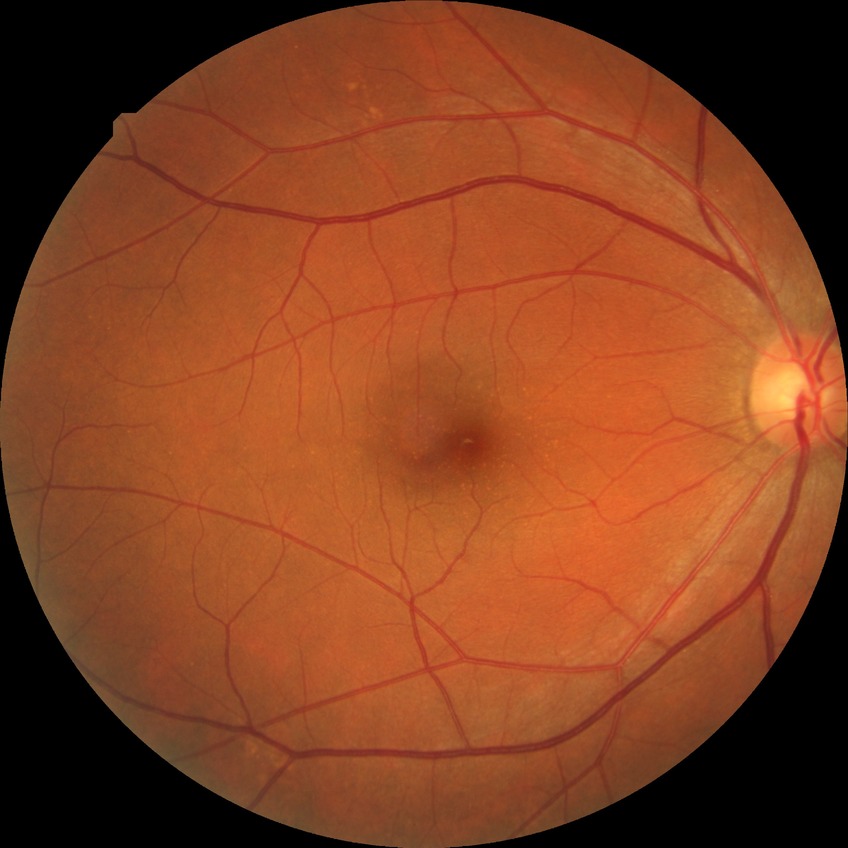 Diabetic retinopathy (DR): NDR (no diabetic retinopathy).